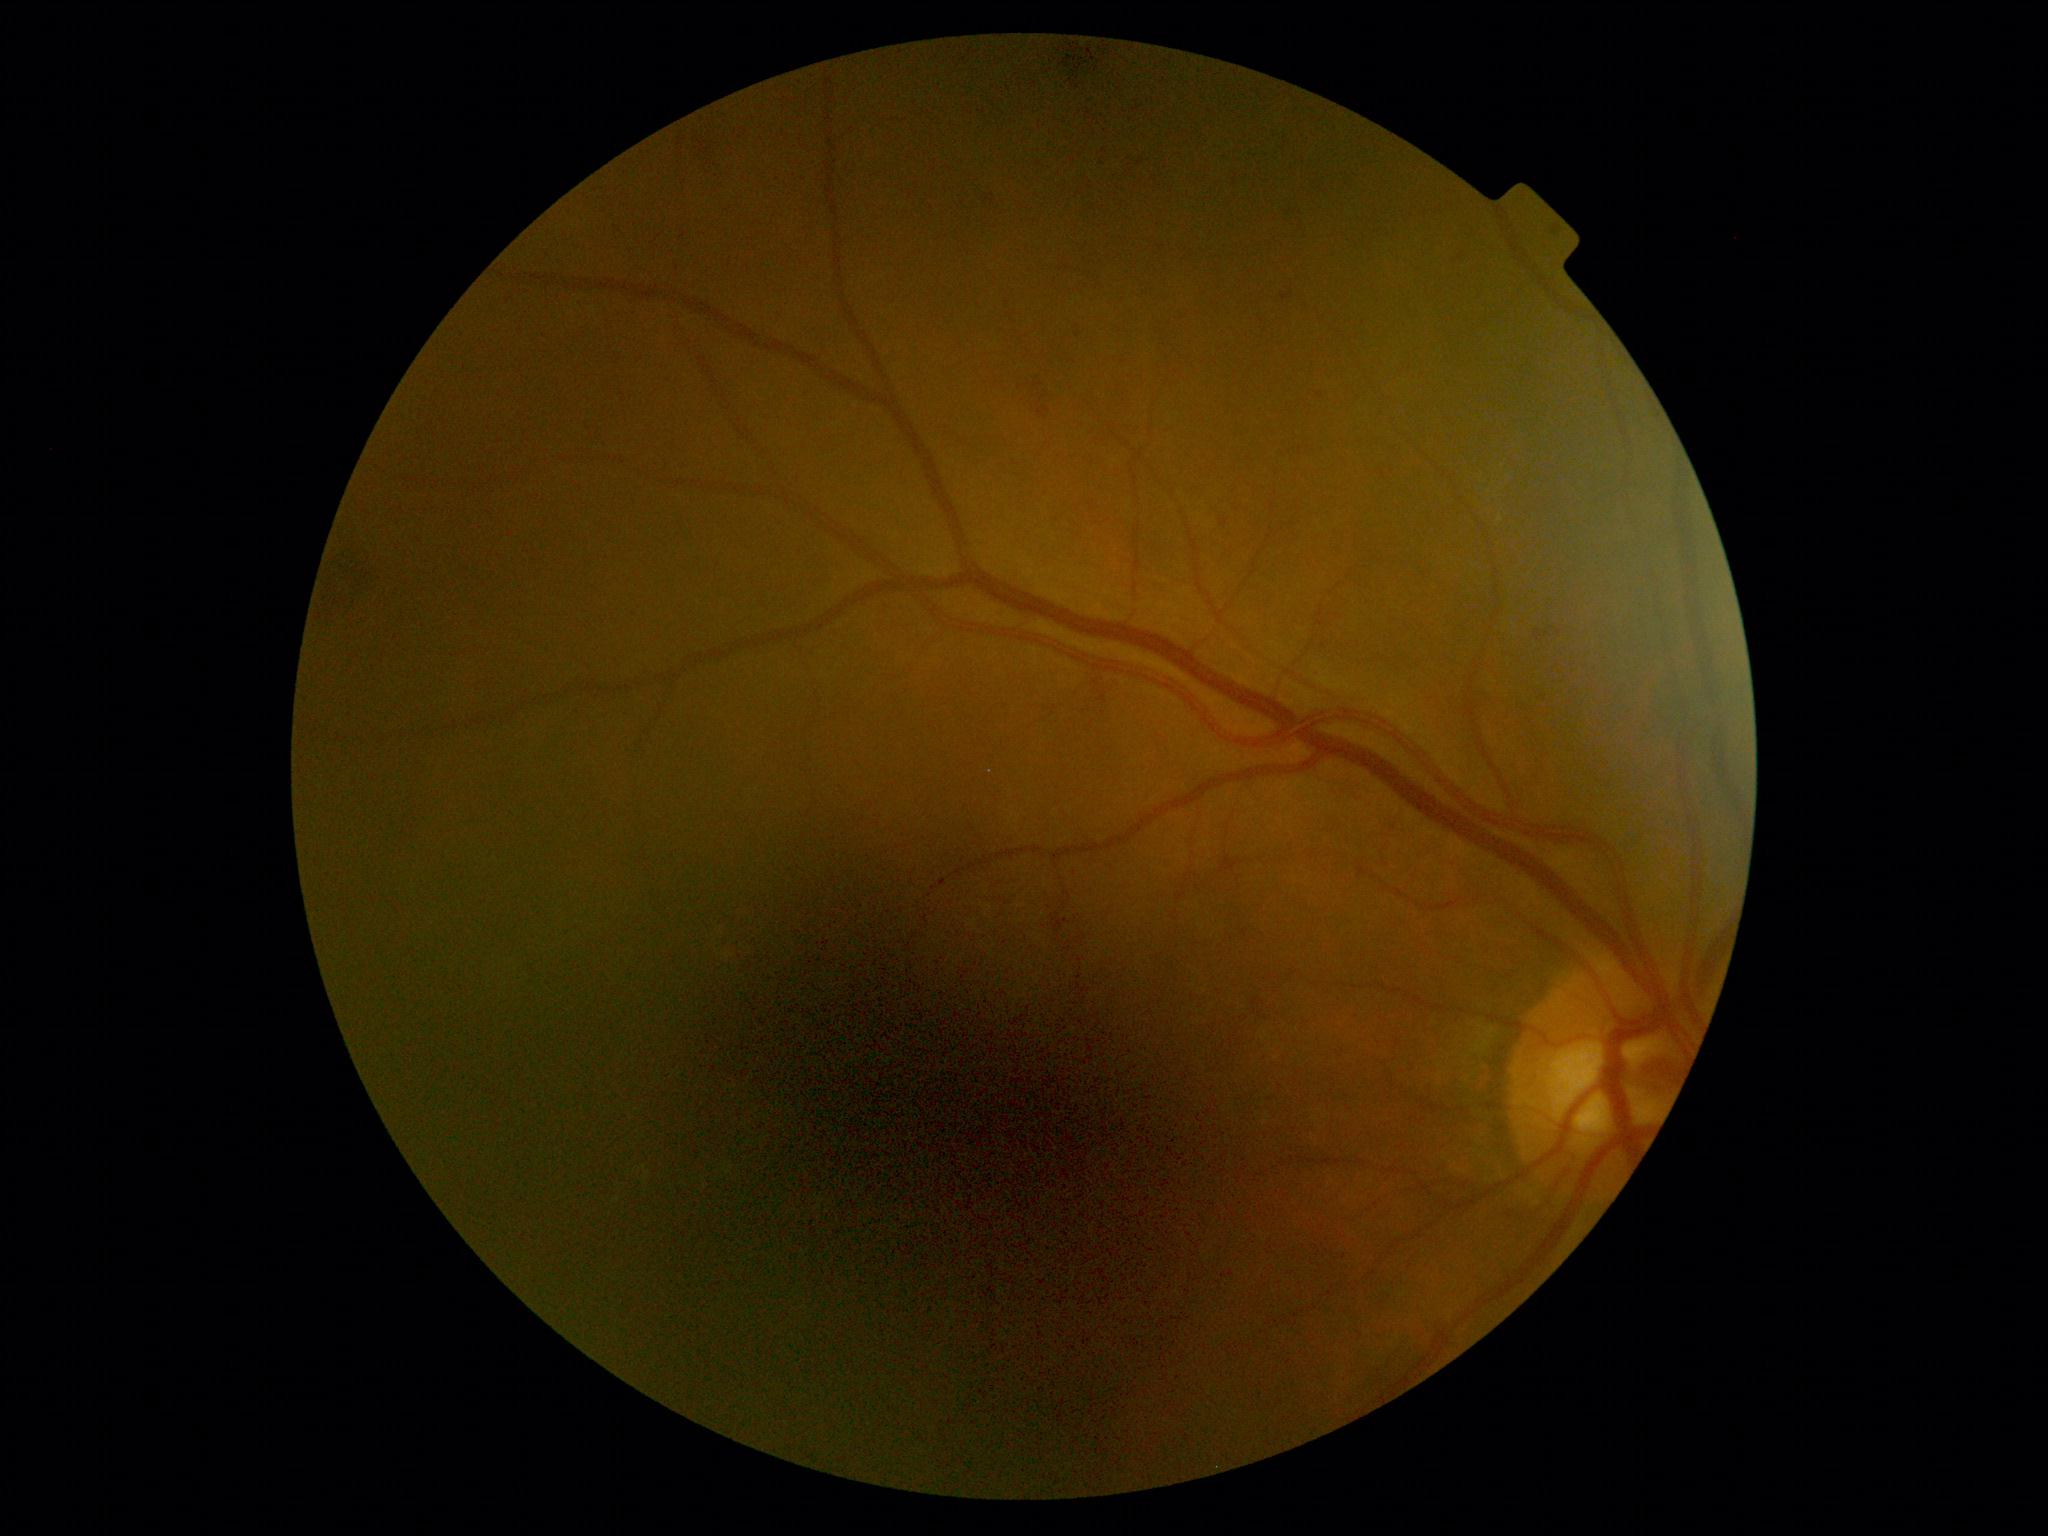

Diabetic retinopathy is moderate NPDR (grade 2).